Wide-field fundus photograph of an infant. Camera: Natus RetCam Envision (130° FOV)
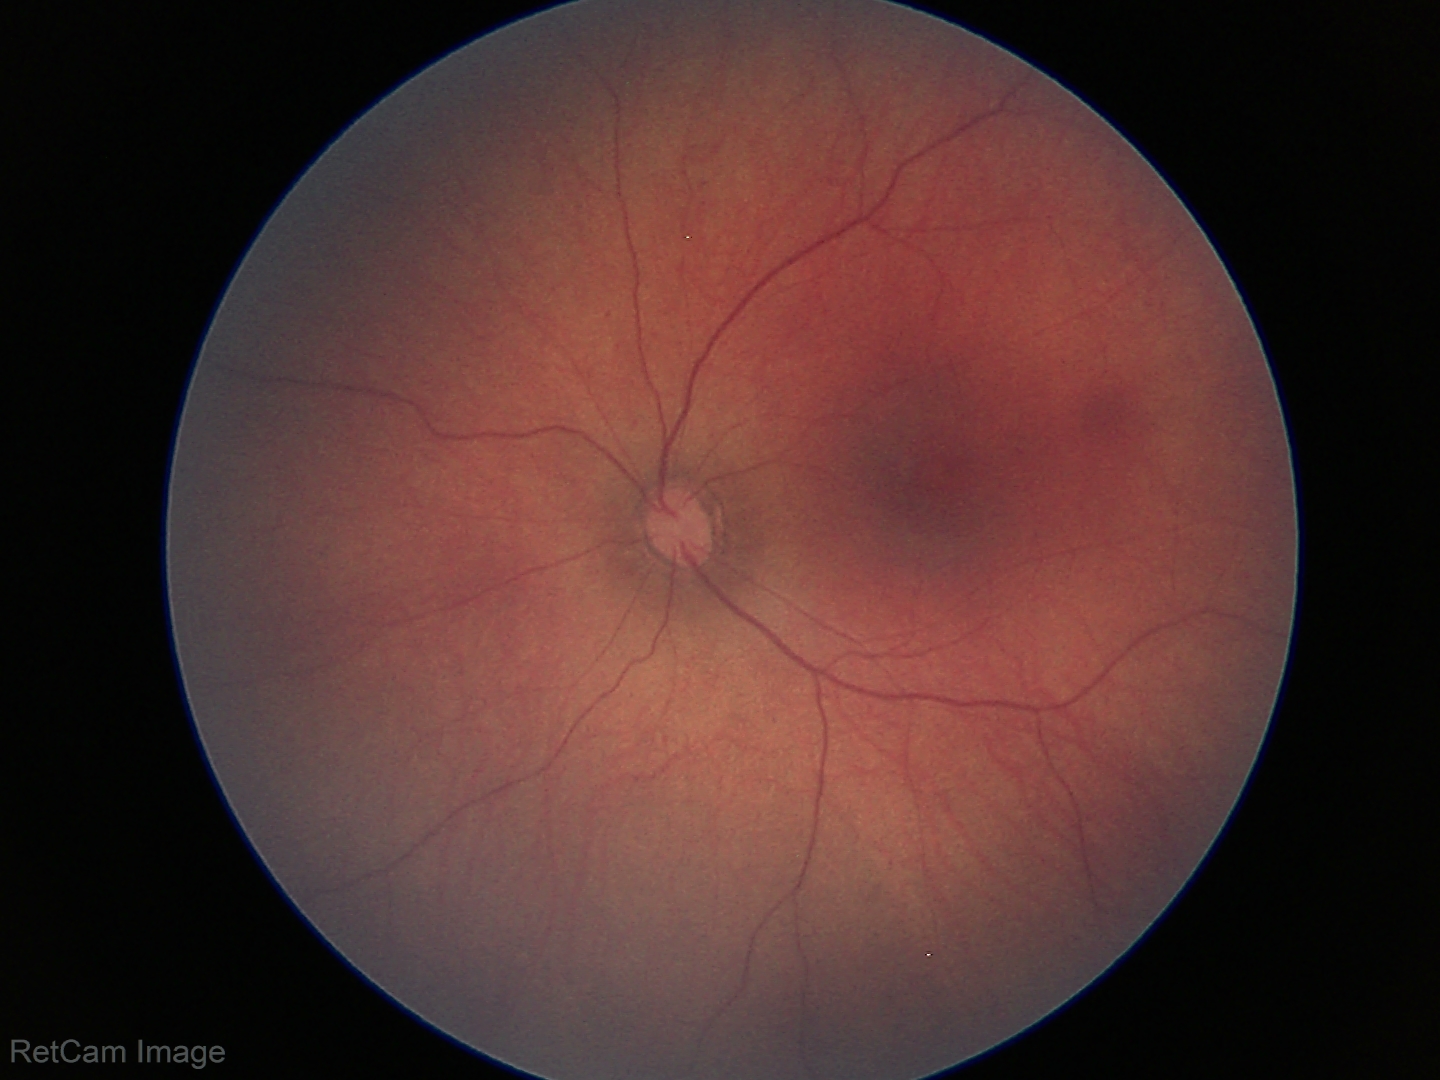
Screening examination diagnosed as physiological.